Ultra-widefield fundus mosaic:
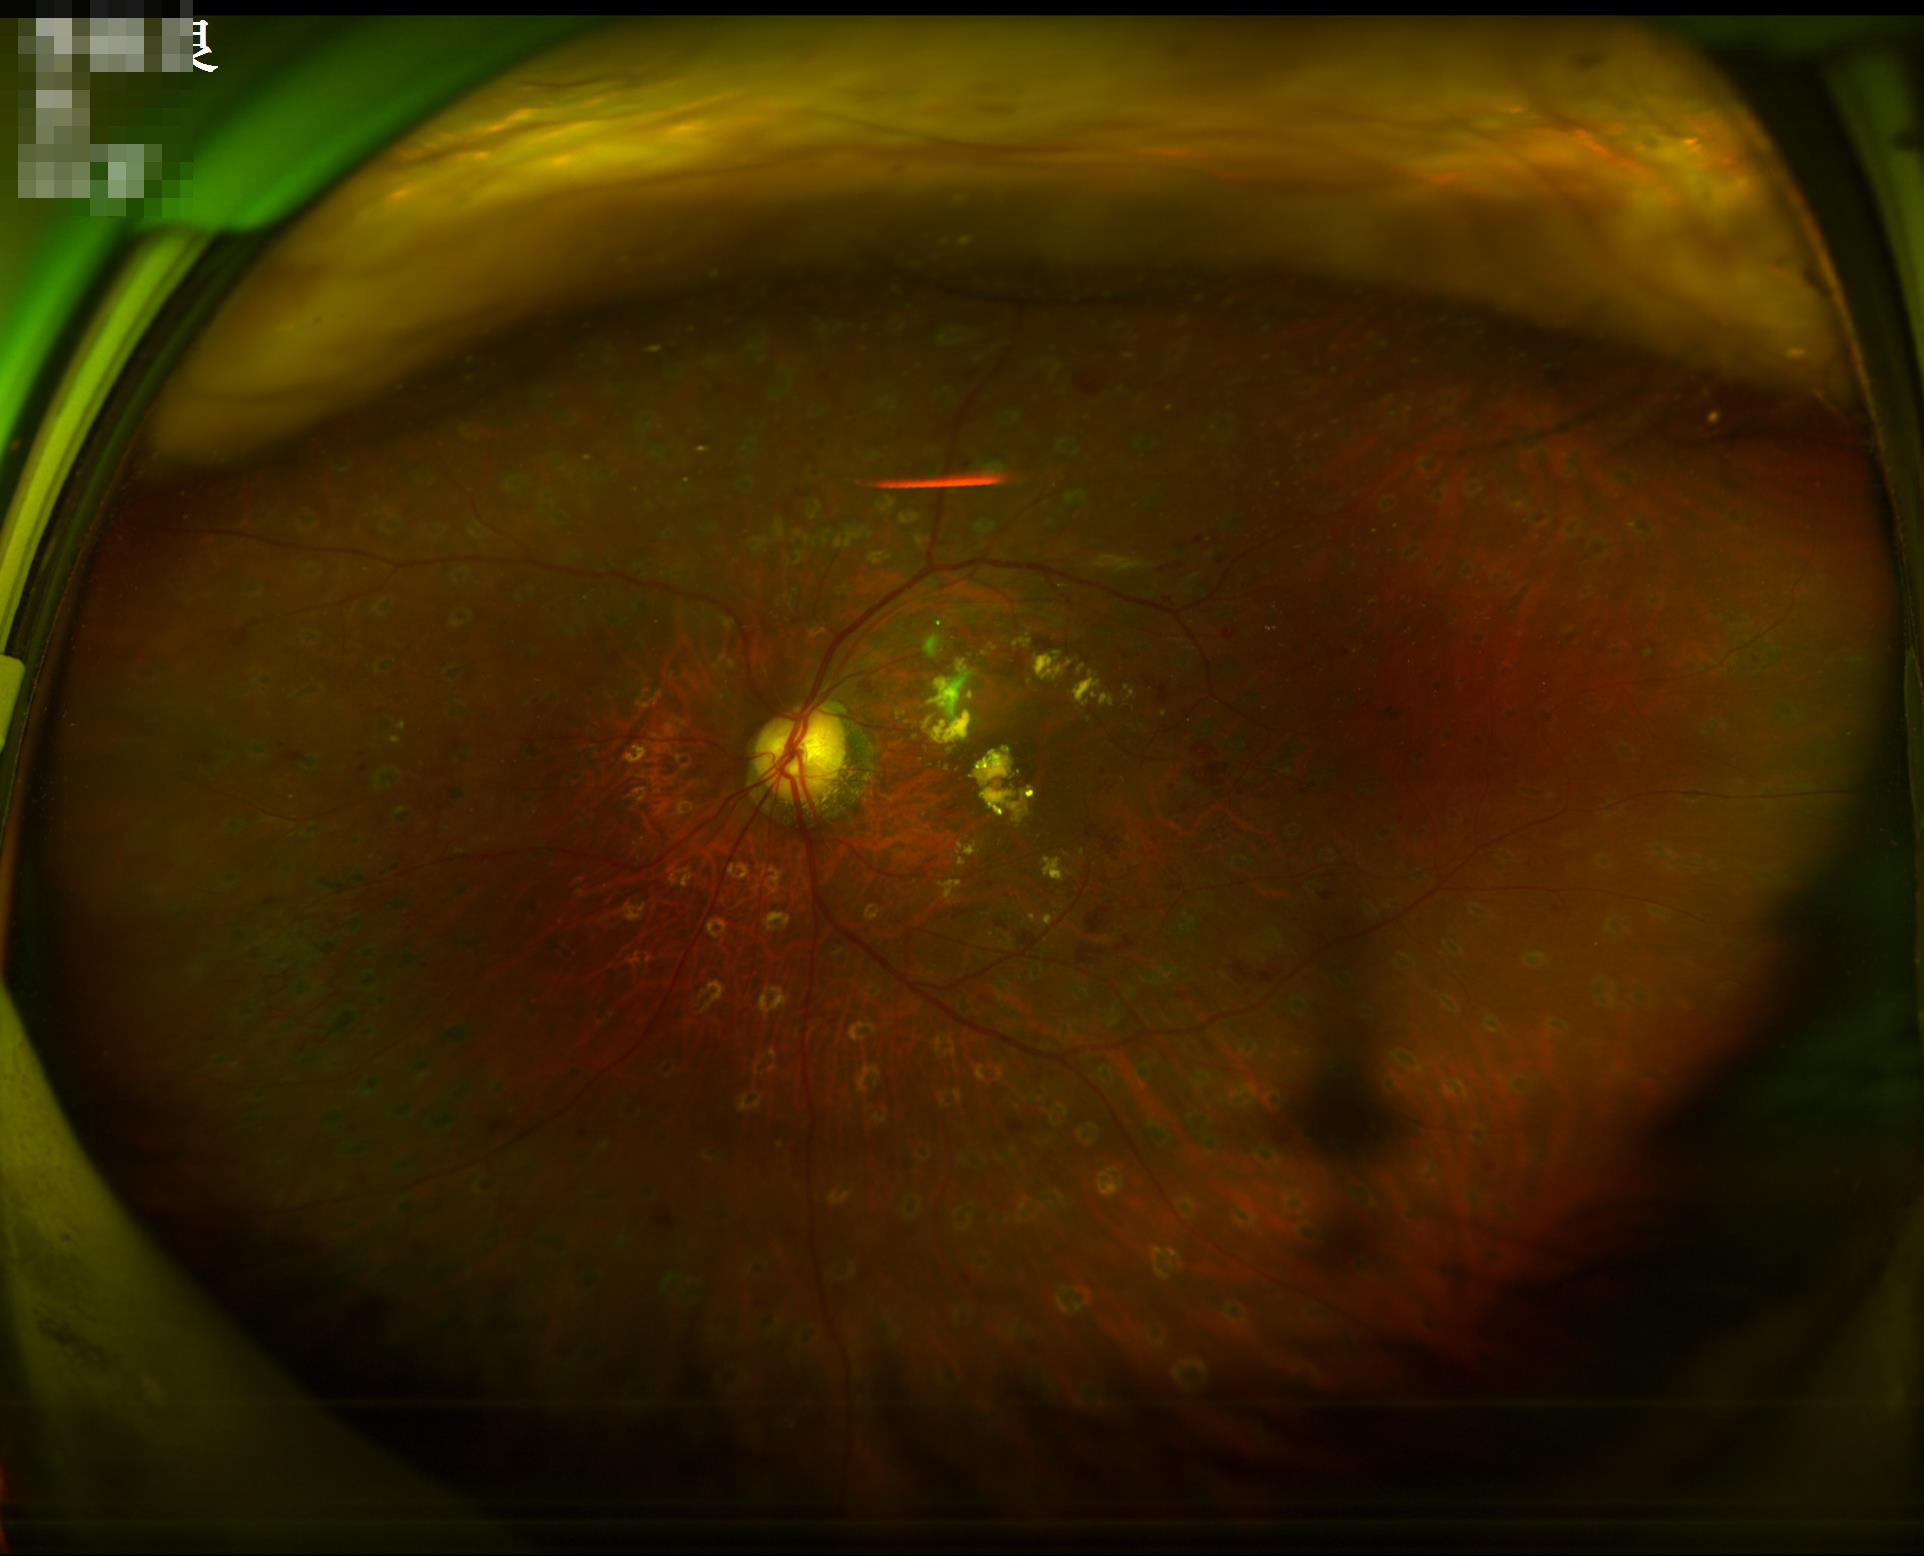
Illumination is uneven.
Contrast is good.
Overall image quality is good.